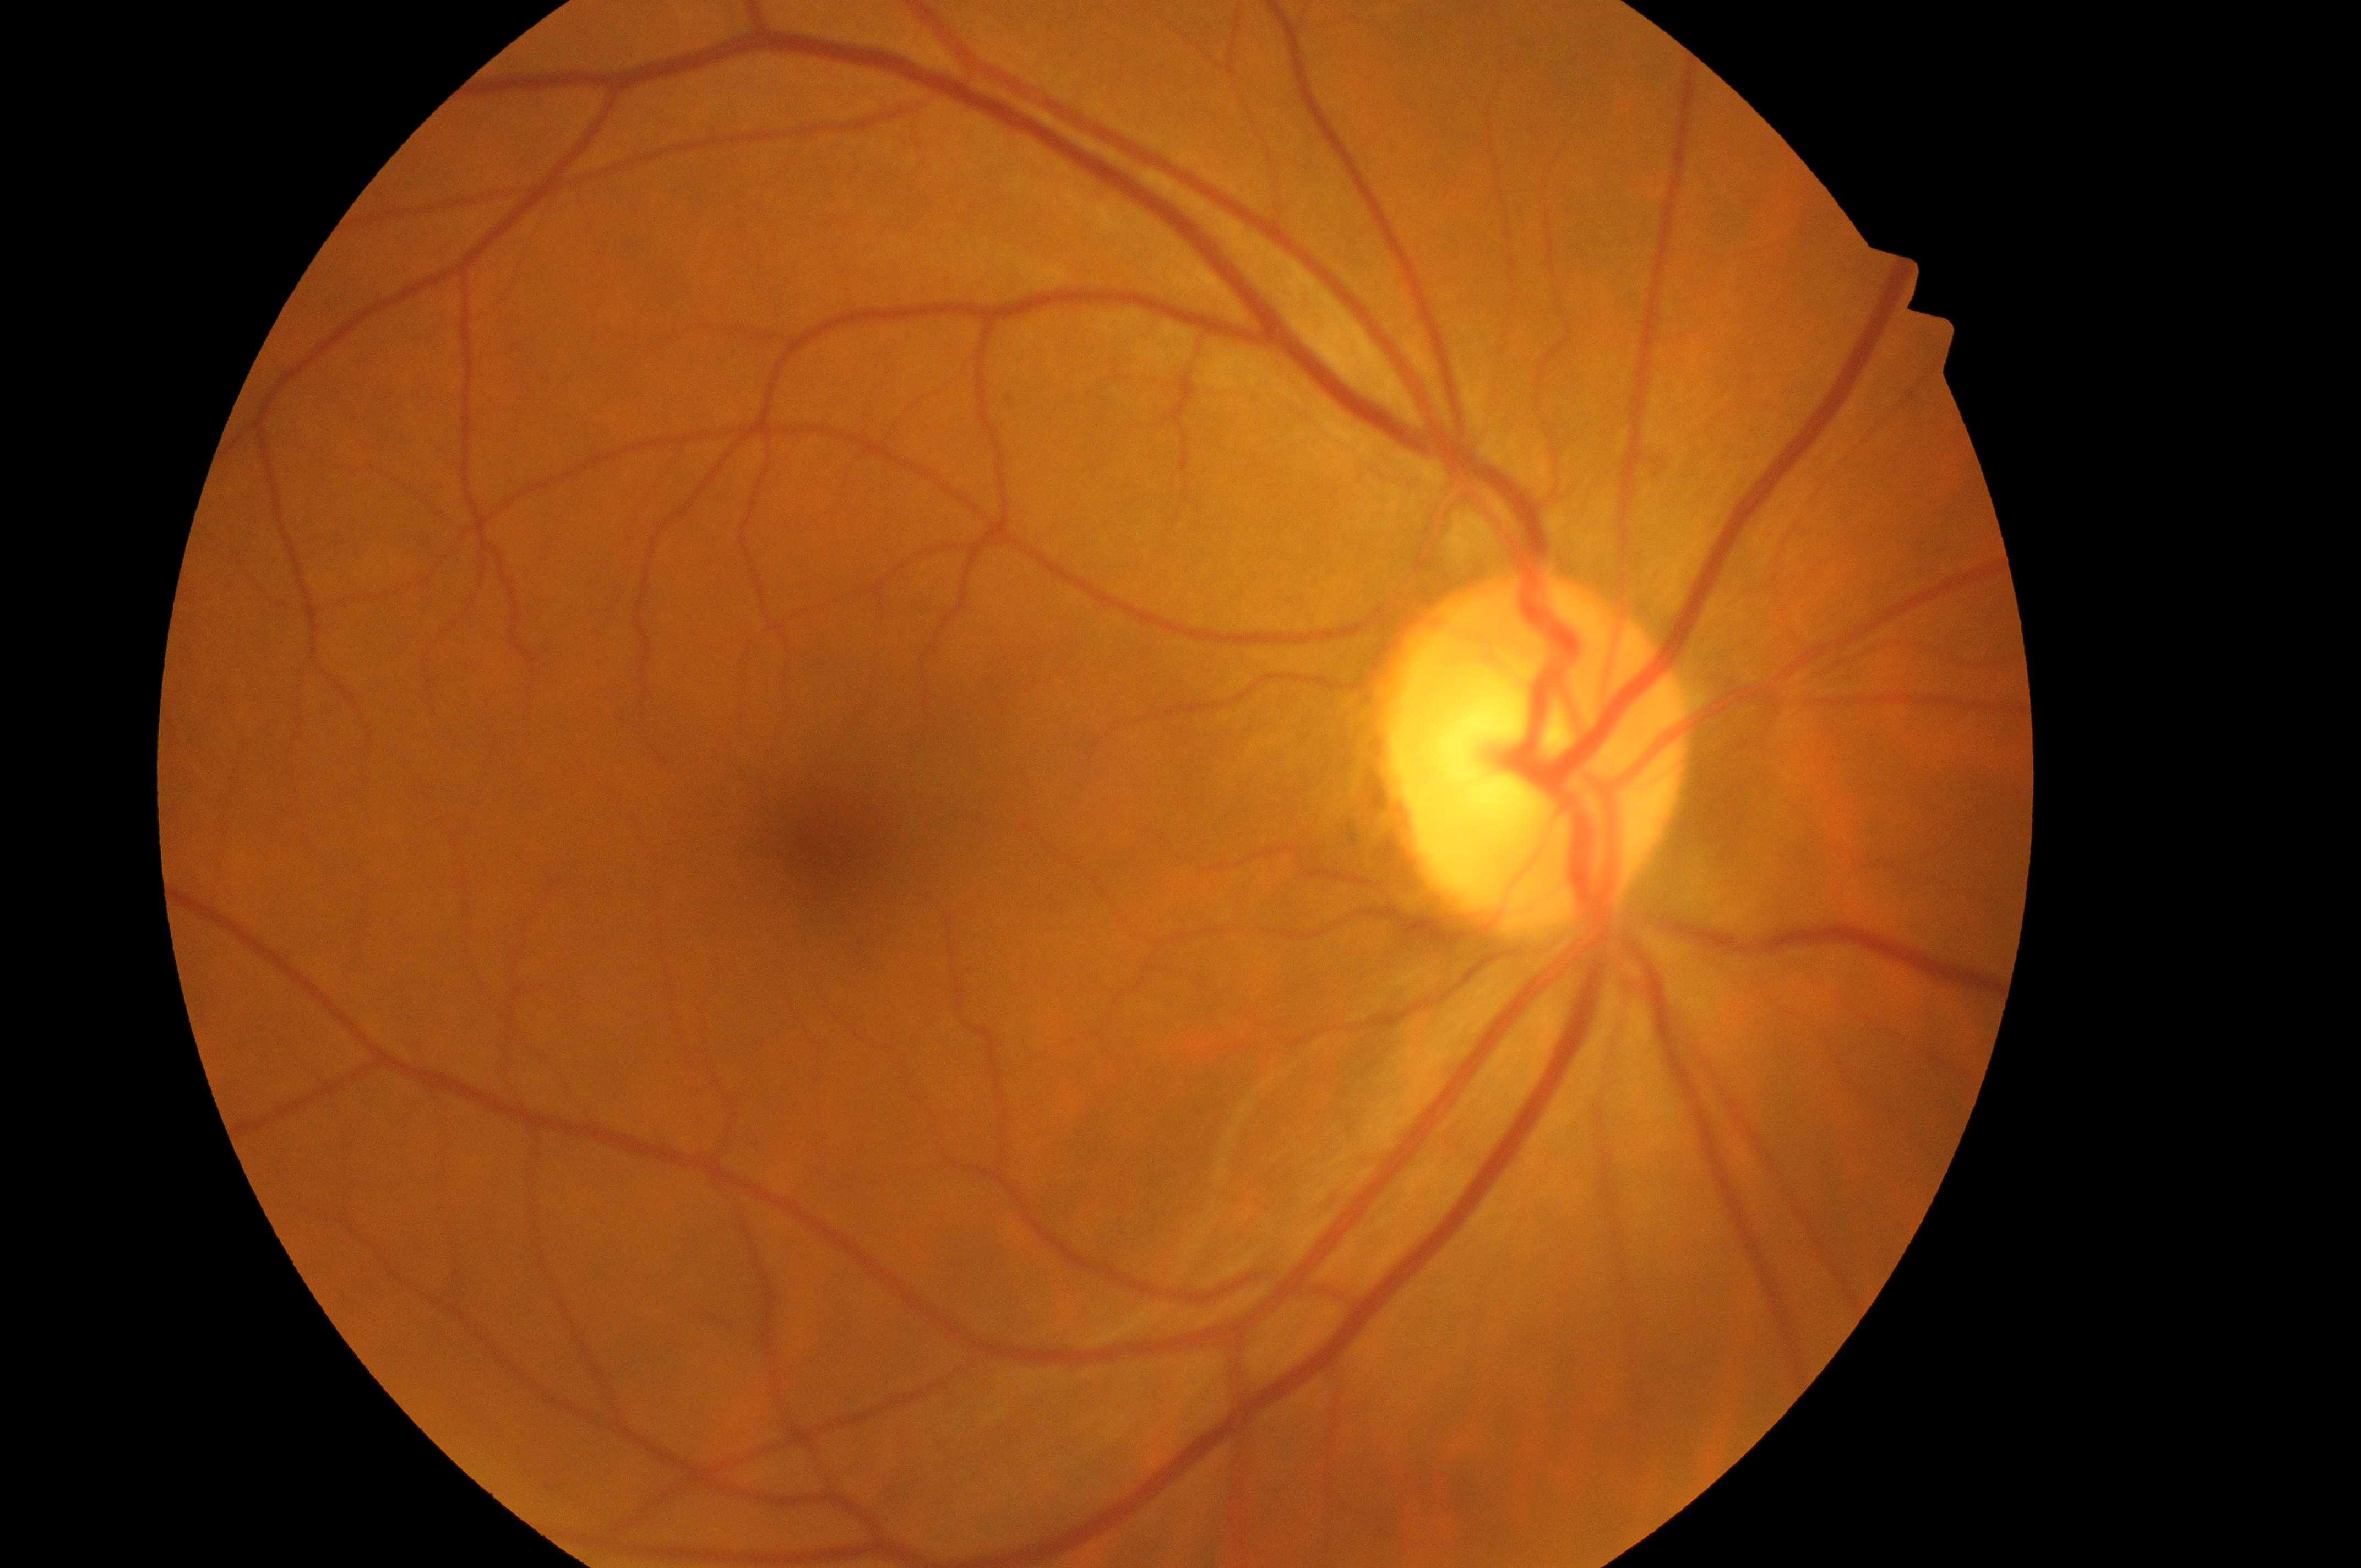

No diabetic retinal disease findings.
DR: no apparent retinopathy (grade 0).
Optic disc located at 1532, 771.
The fovea center is at 835, 851.
Eye: right eye.
DME grade: 0 (no risk).